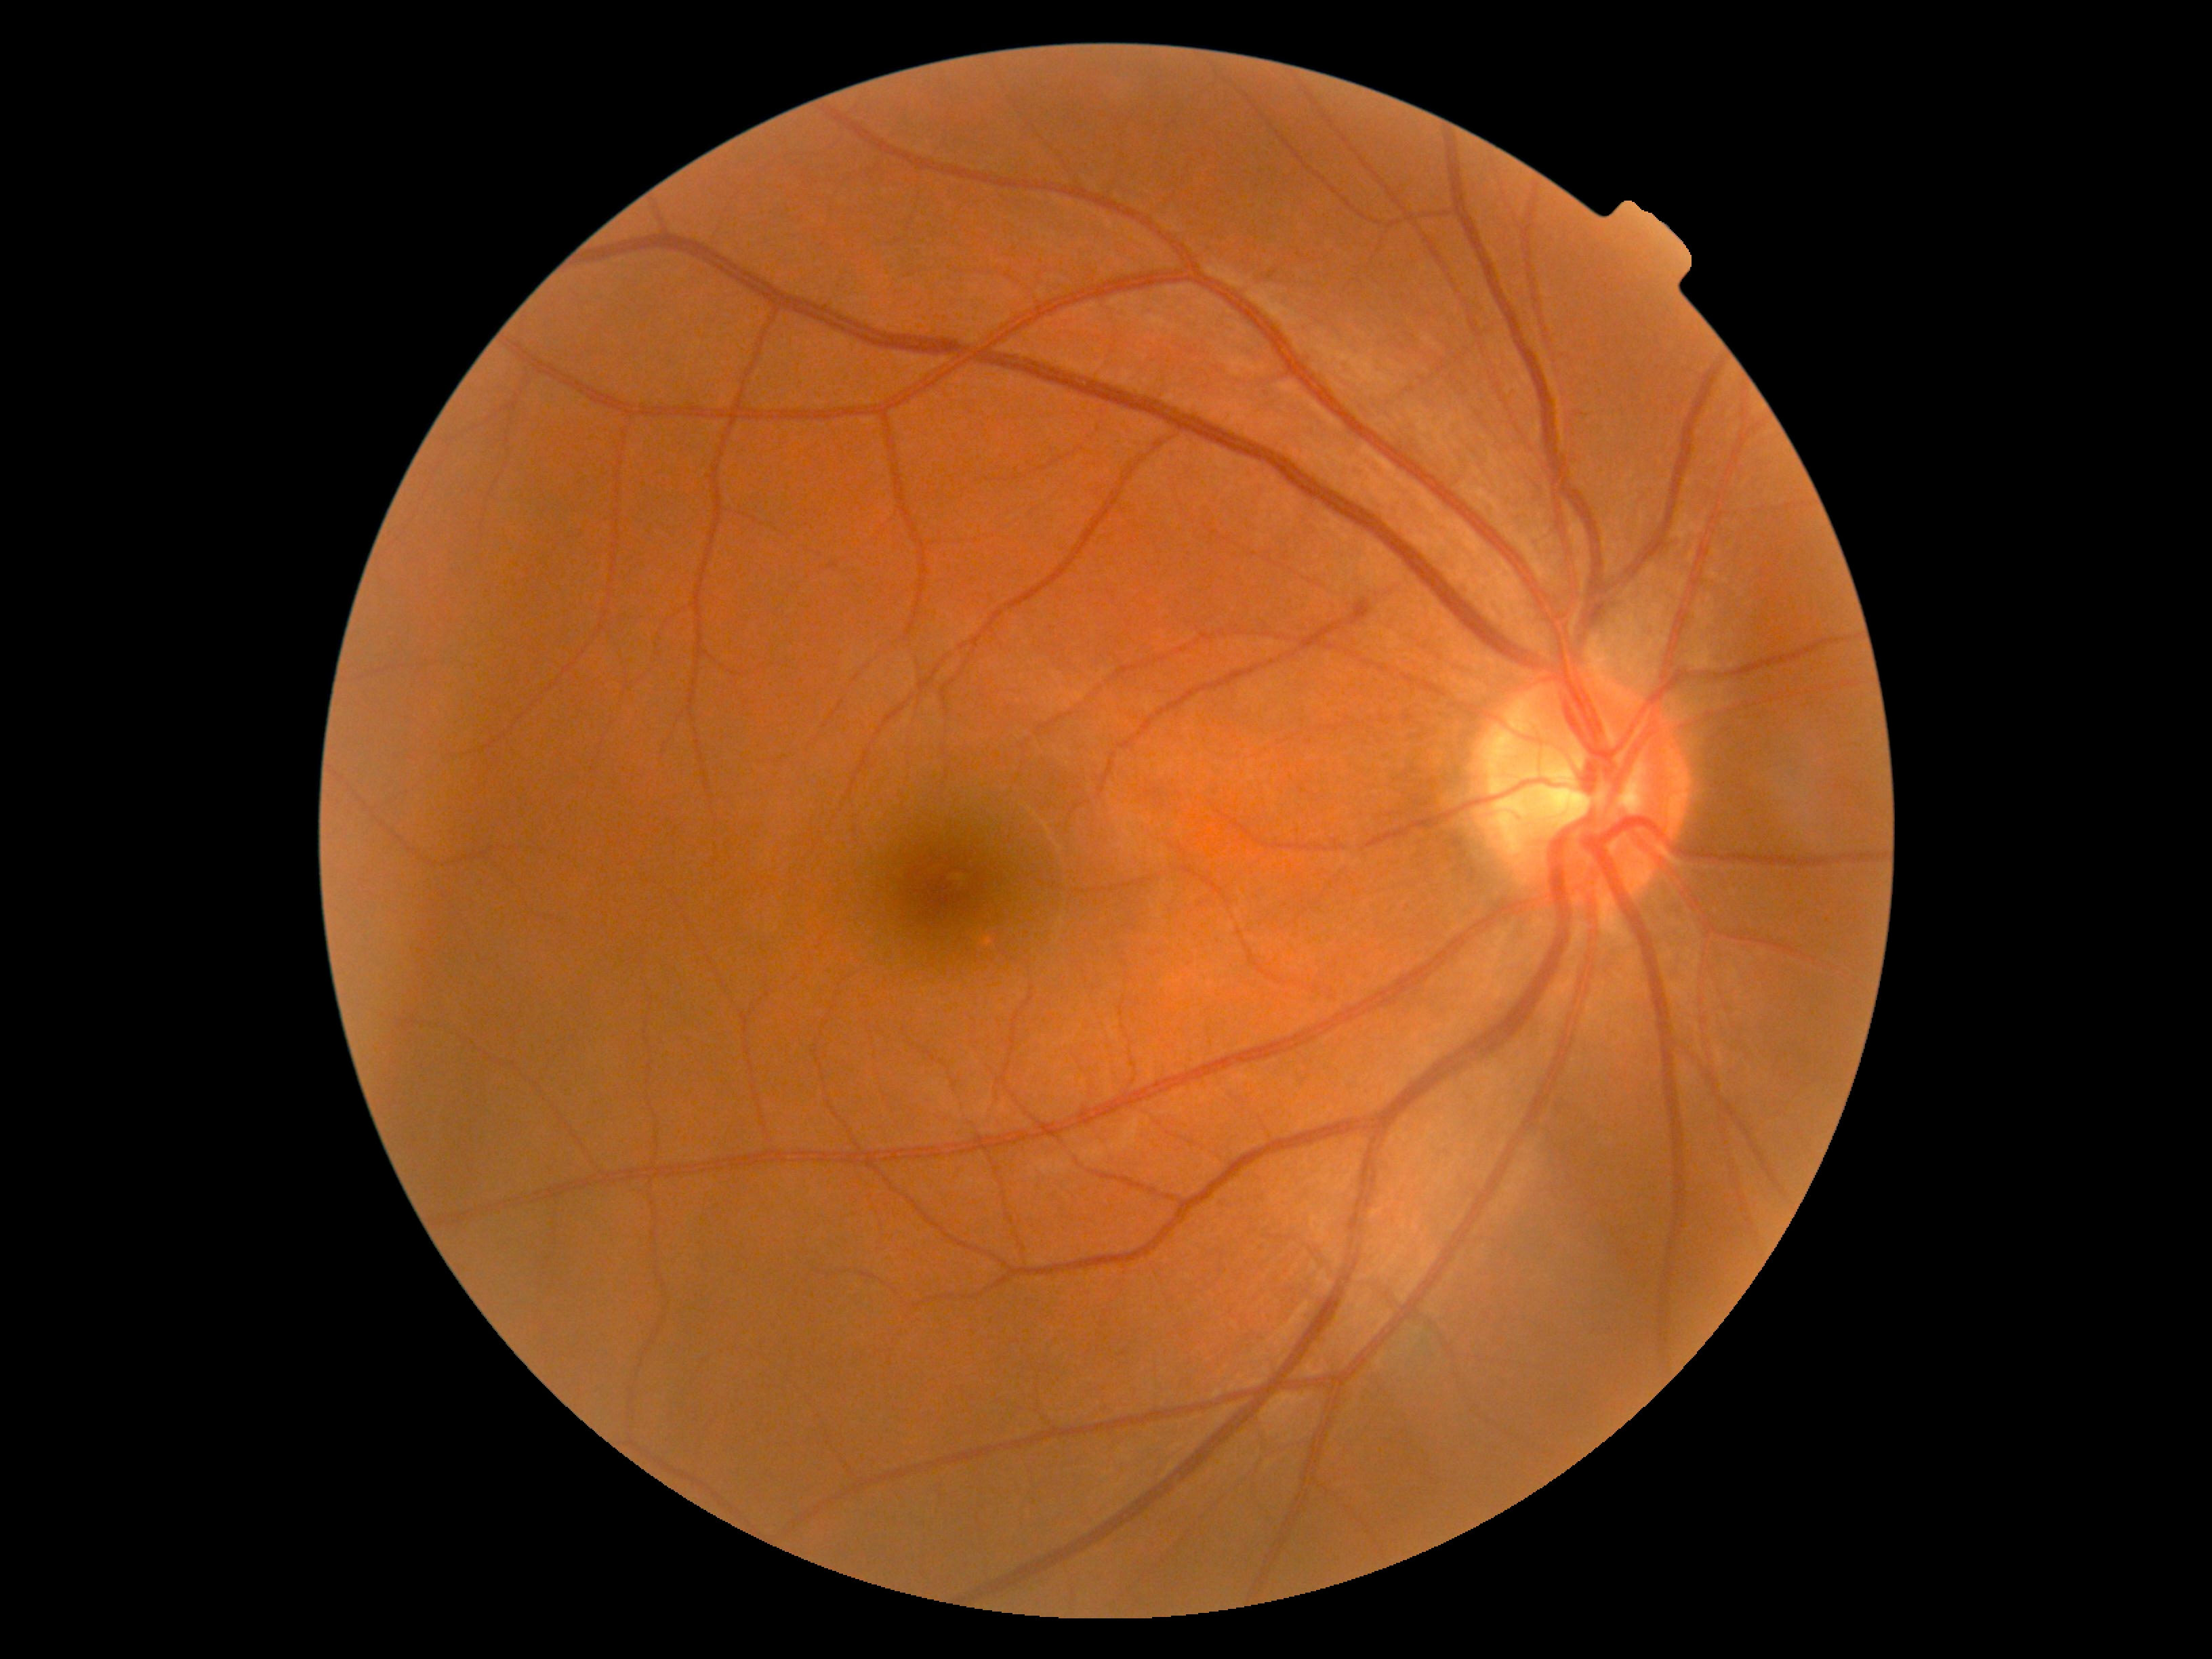 No DR findings. Retinopathy grade: 0 (no apparent retinopathy).